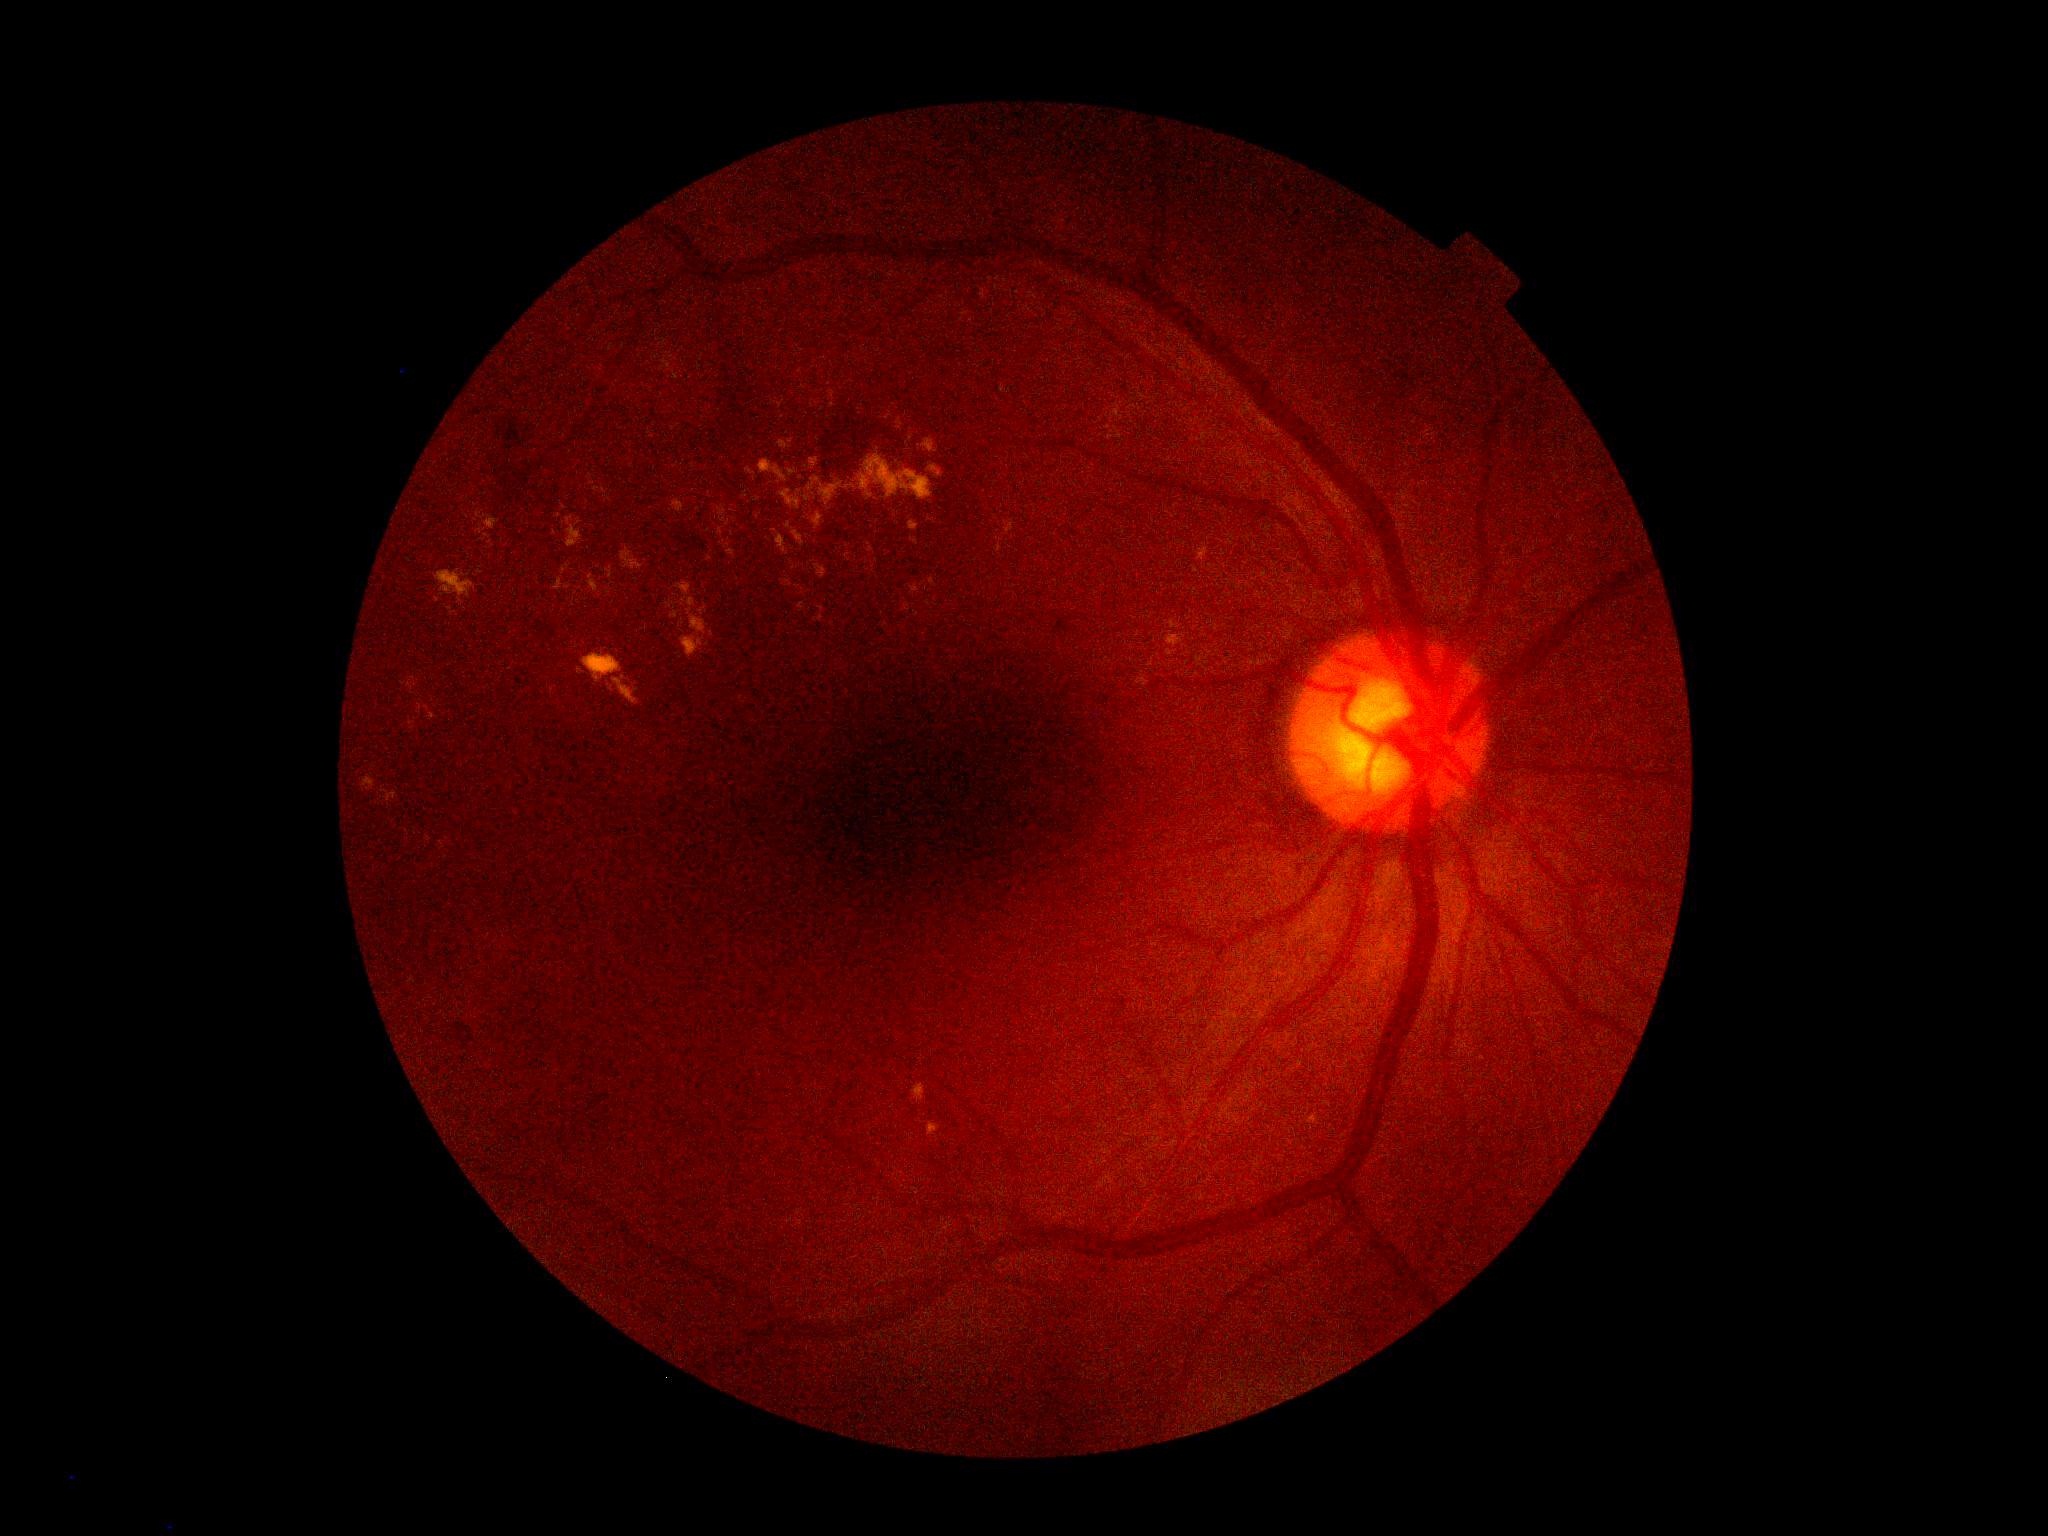

retinopathy grade: moderate non-proliferative diabetic retinopathy (2); DR class: non-proliferative diabetic retinopathy.